No pharmacologic dilation · 45° field of view:
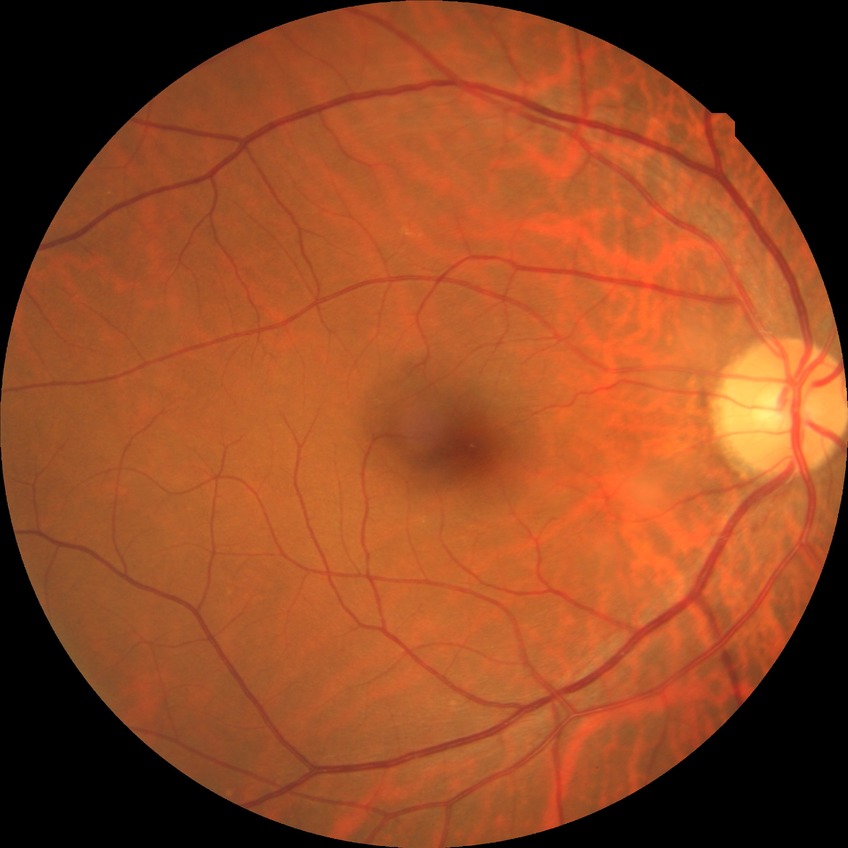 – Davis grading — no diabetic retinopathy